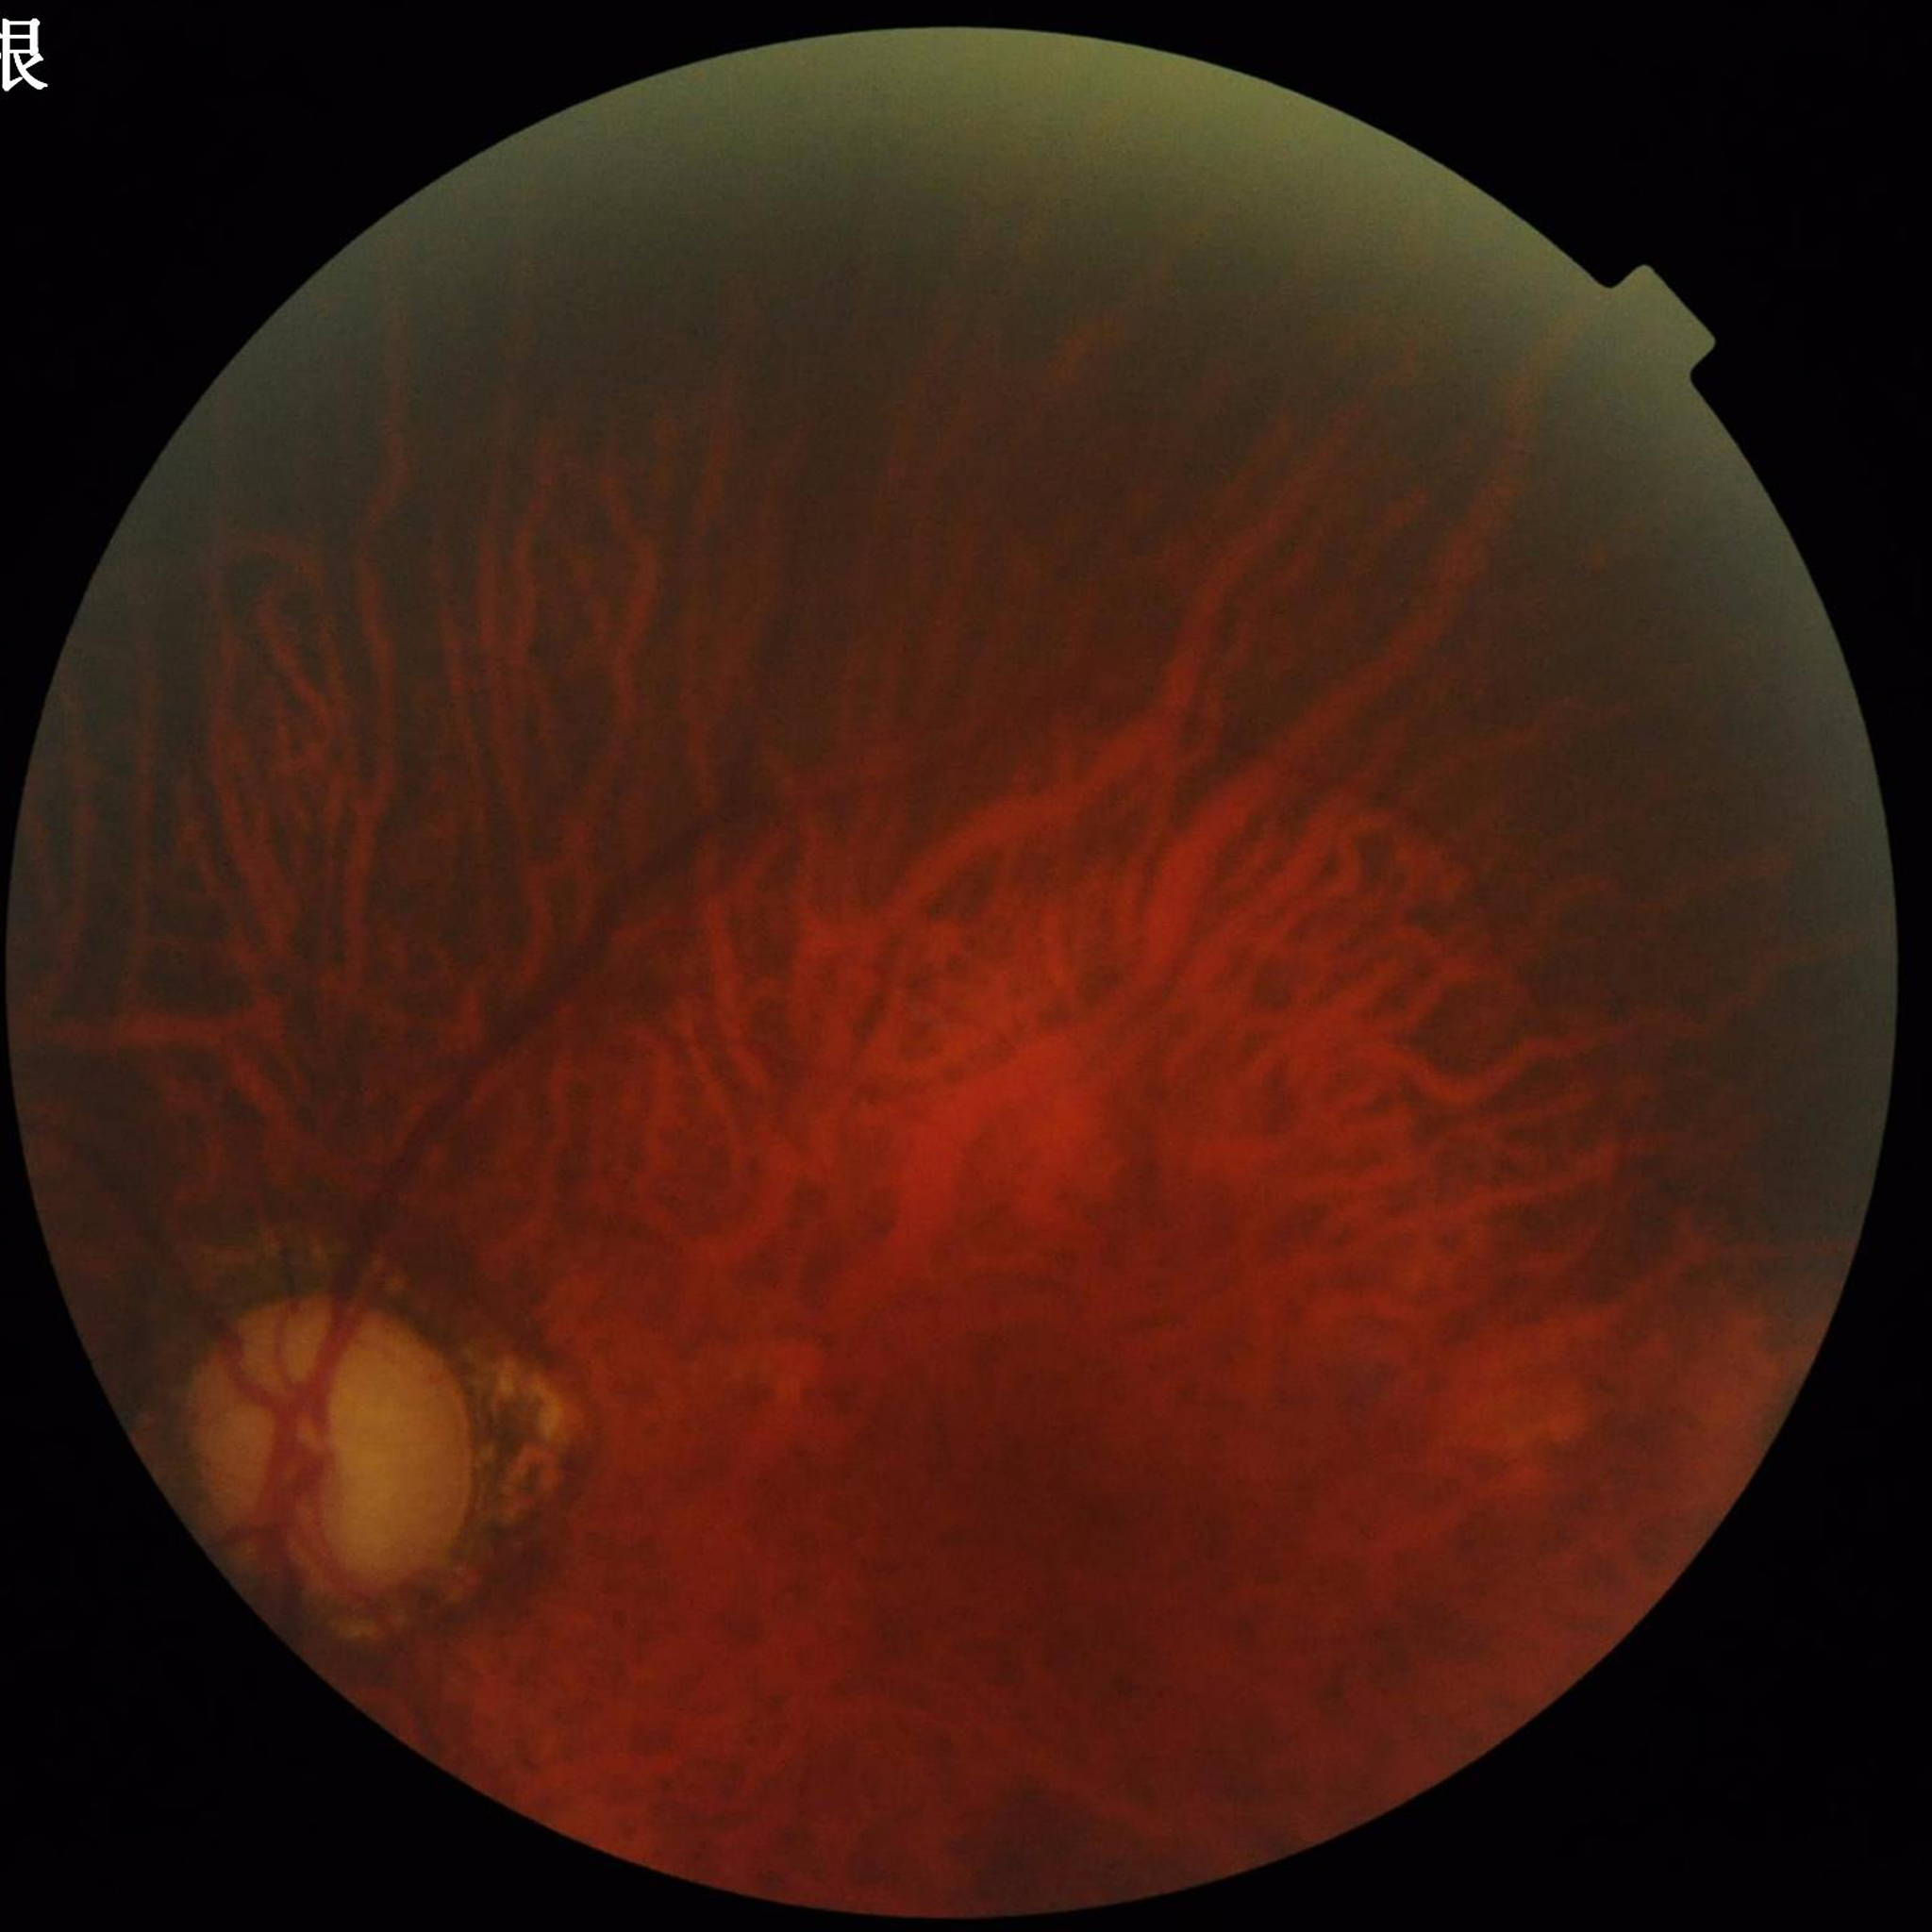
Quality assessment: suboptimal — blur, illumination/color distortion, low contrast | Diagnosis: glaucoma.